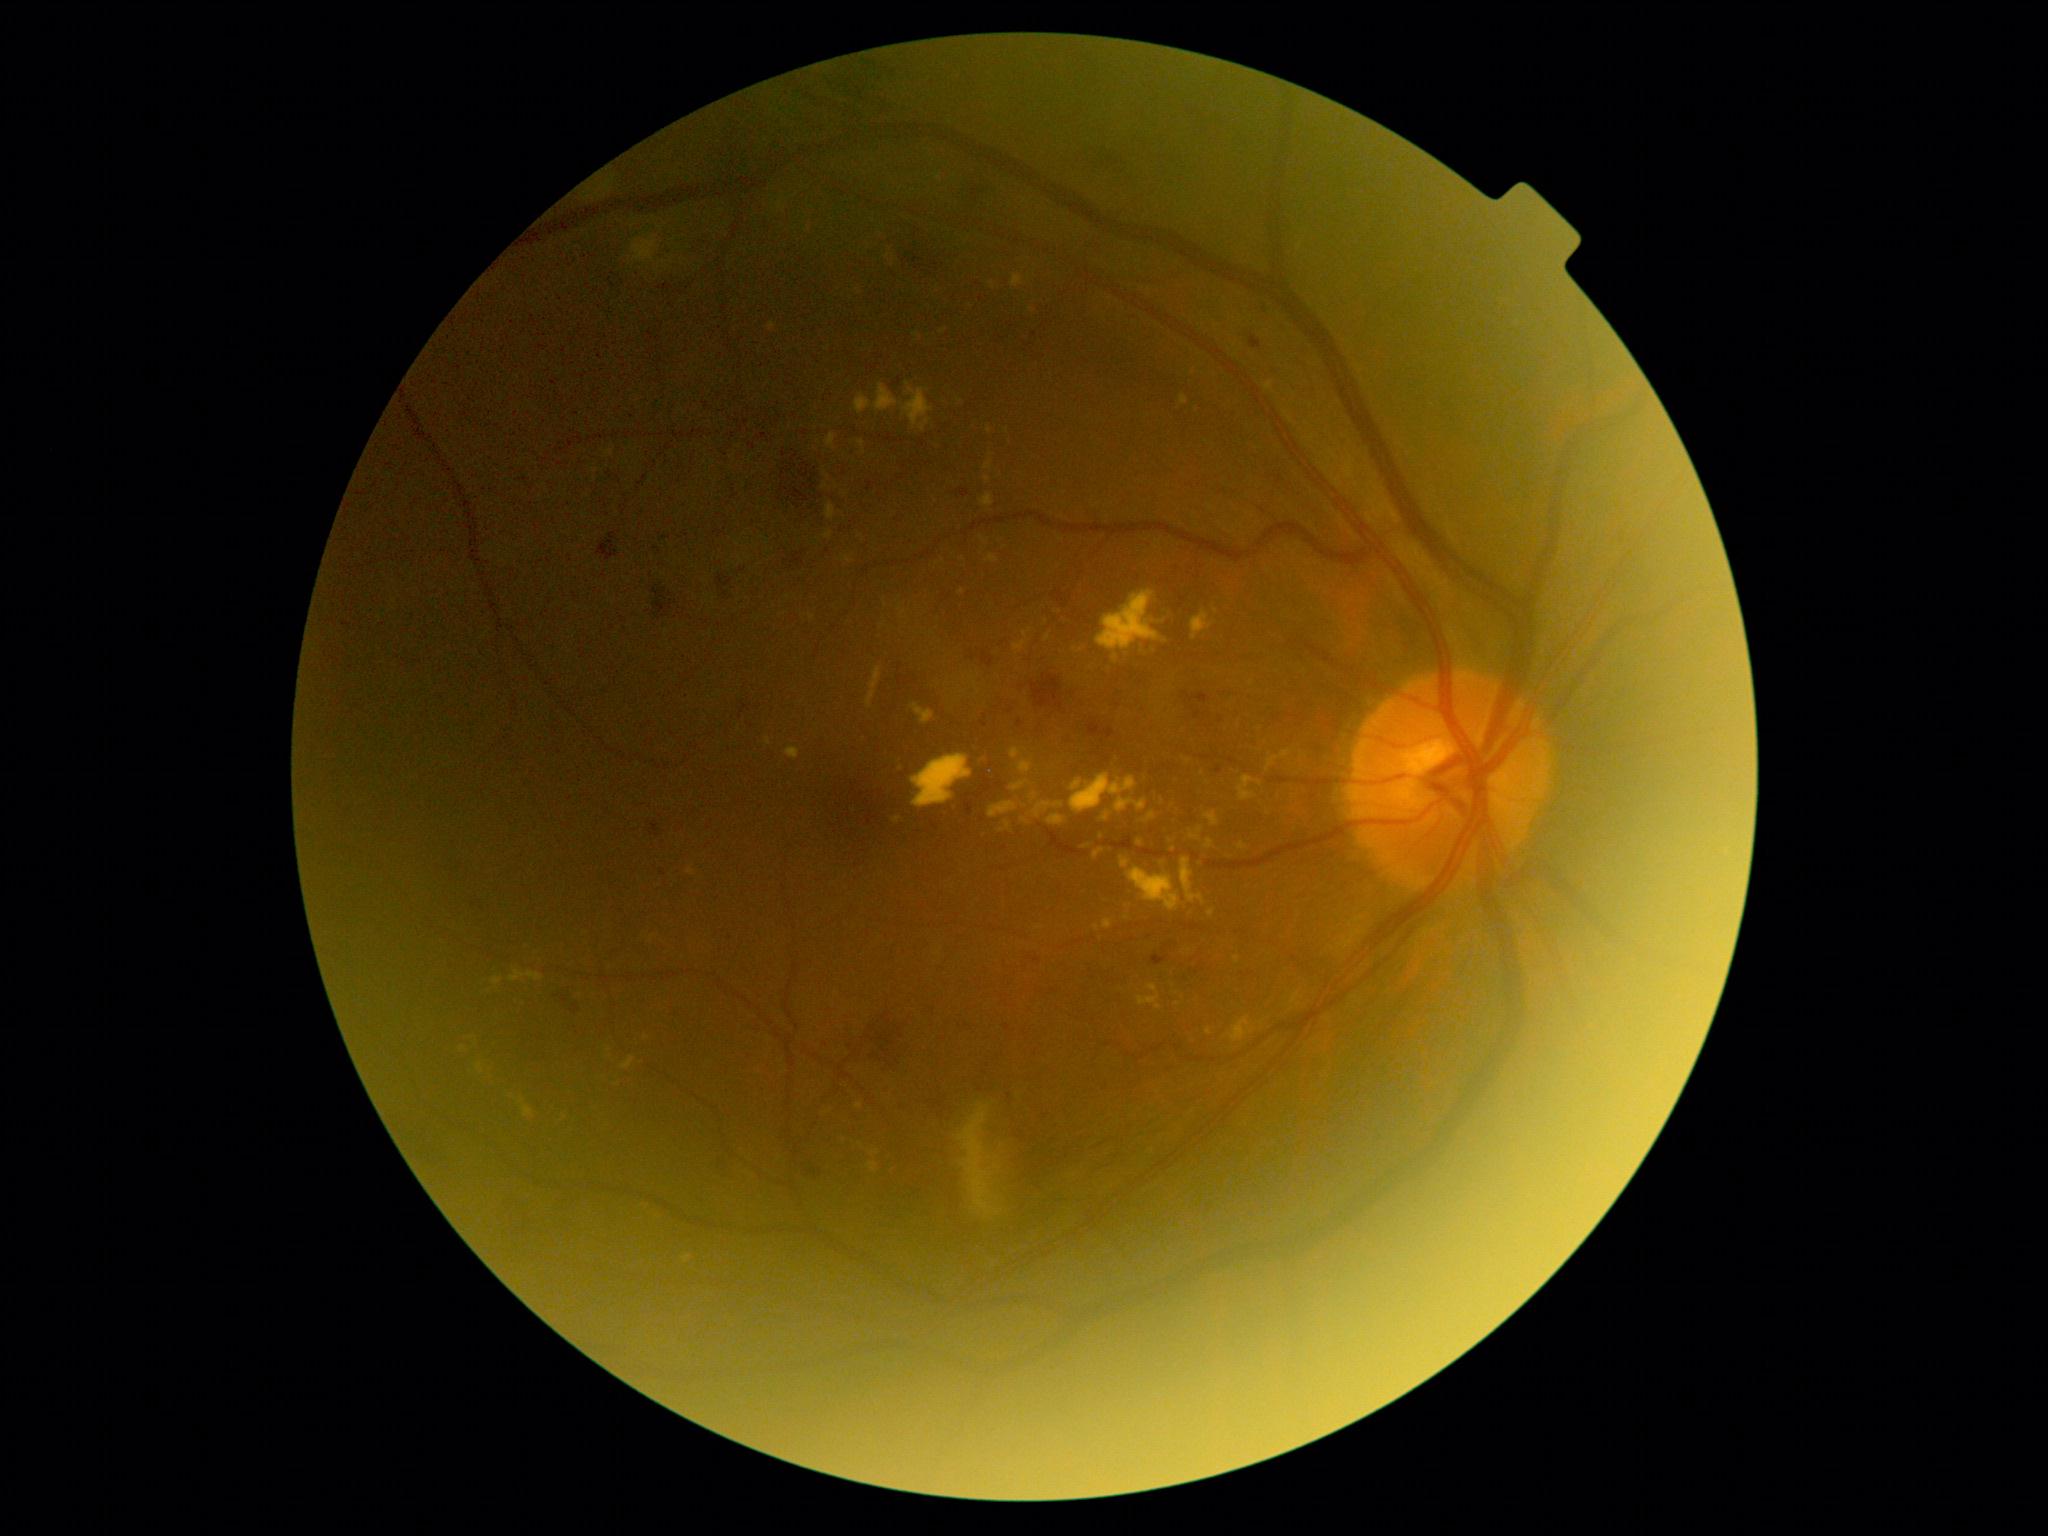 DR class: non-proliferative diabetic retinopathy, retinopathy: moderate NPDR (grade 2).